Without pupil dilation; retinal fundus photograph; modified Davis grading; camera: NIDEK AFC-230
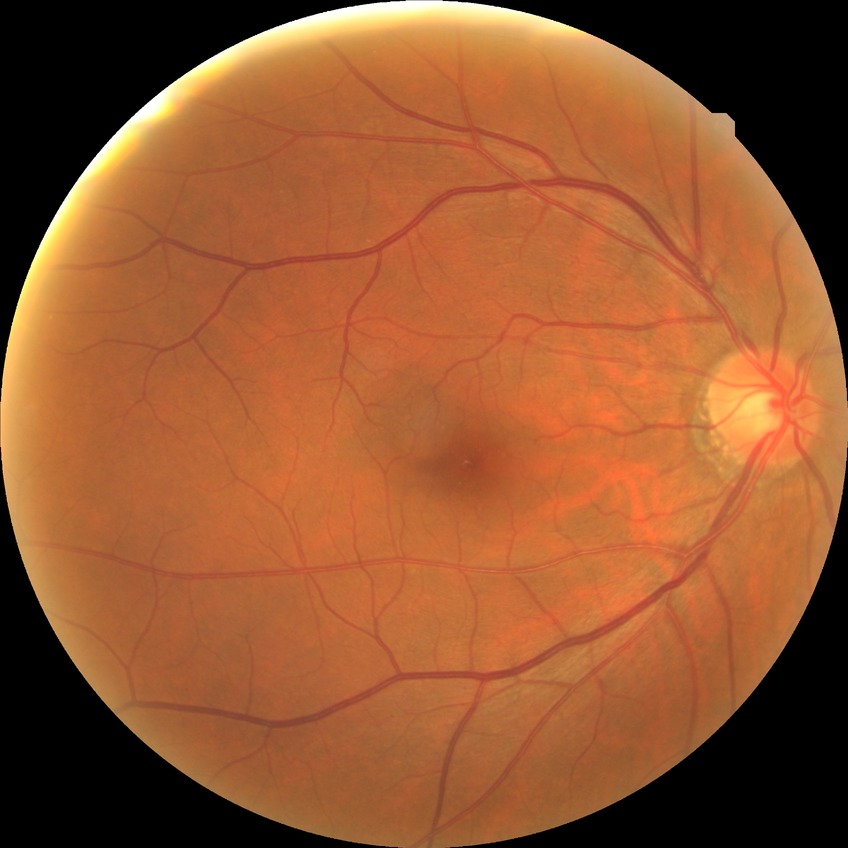
modified Davis grading: no diabetic retinopathy.